Disc-centered fundus crop. 529x529. FOV 35° before cropping.
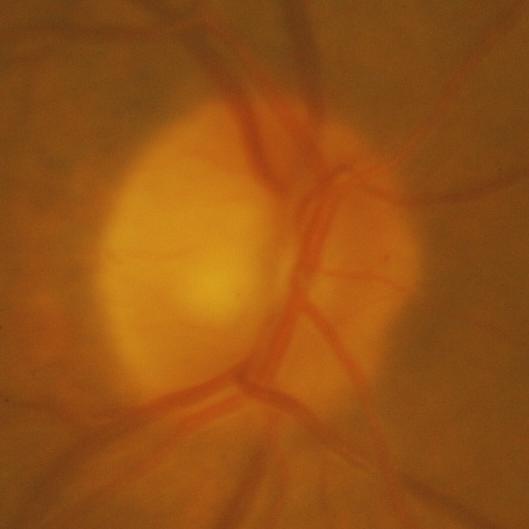
Showing glaucomatous damage to the optic nerve.